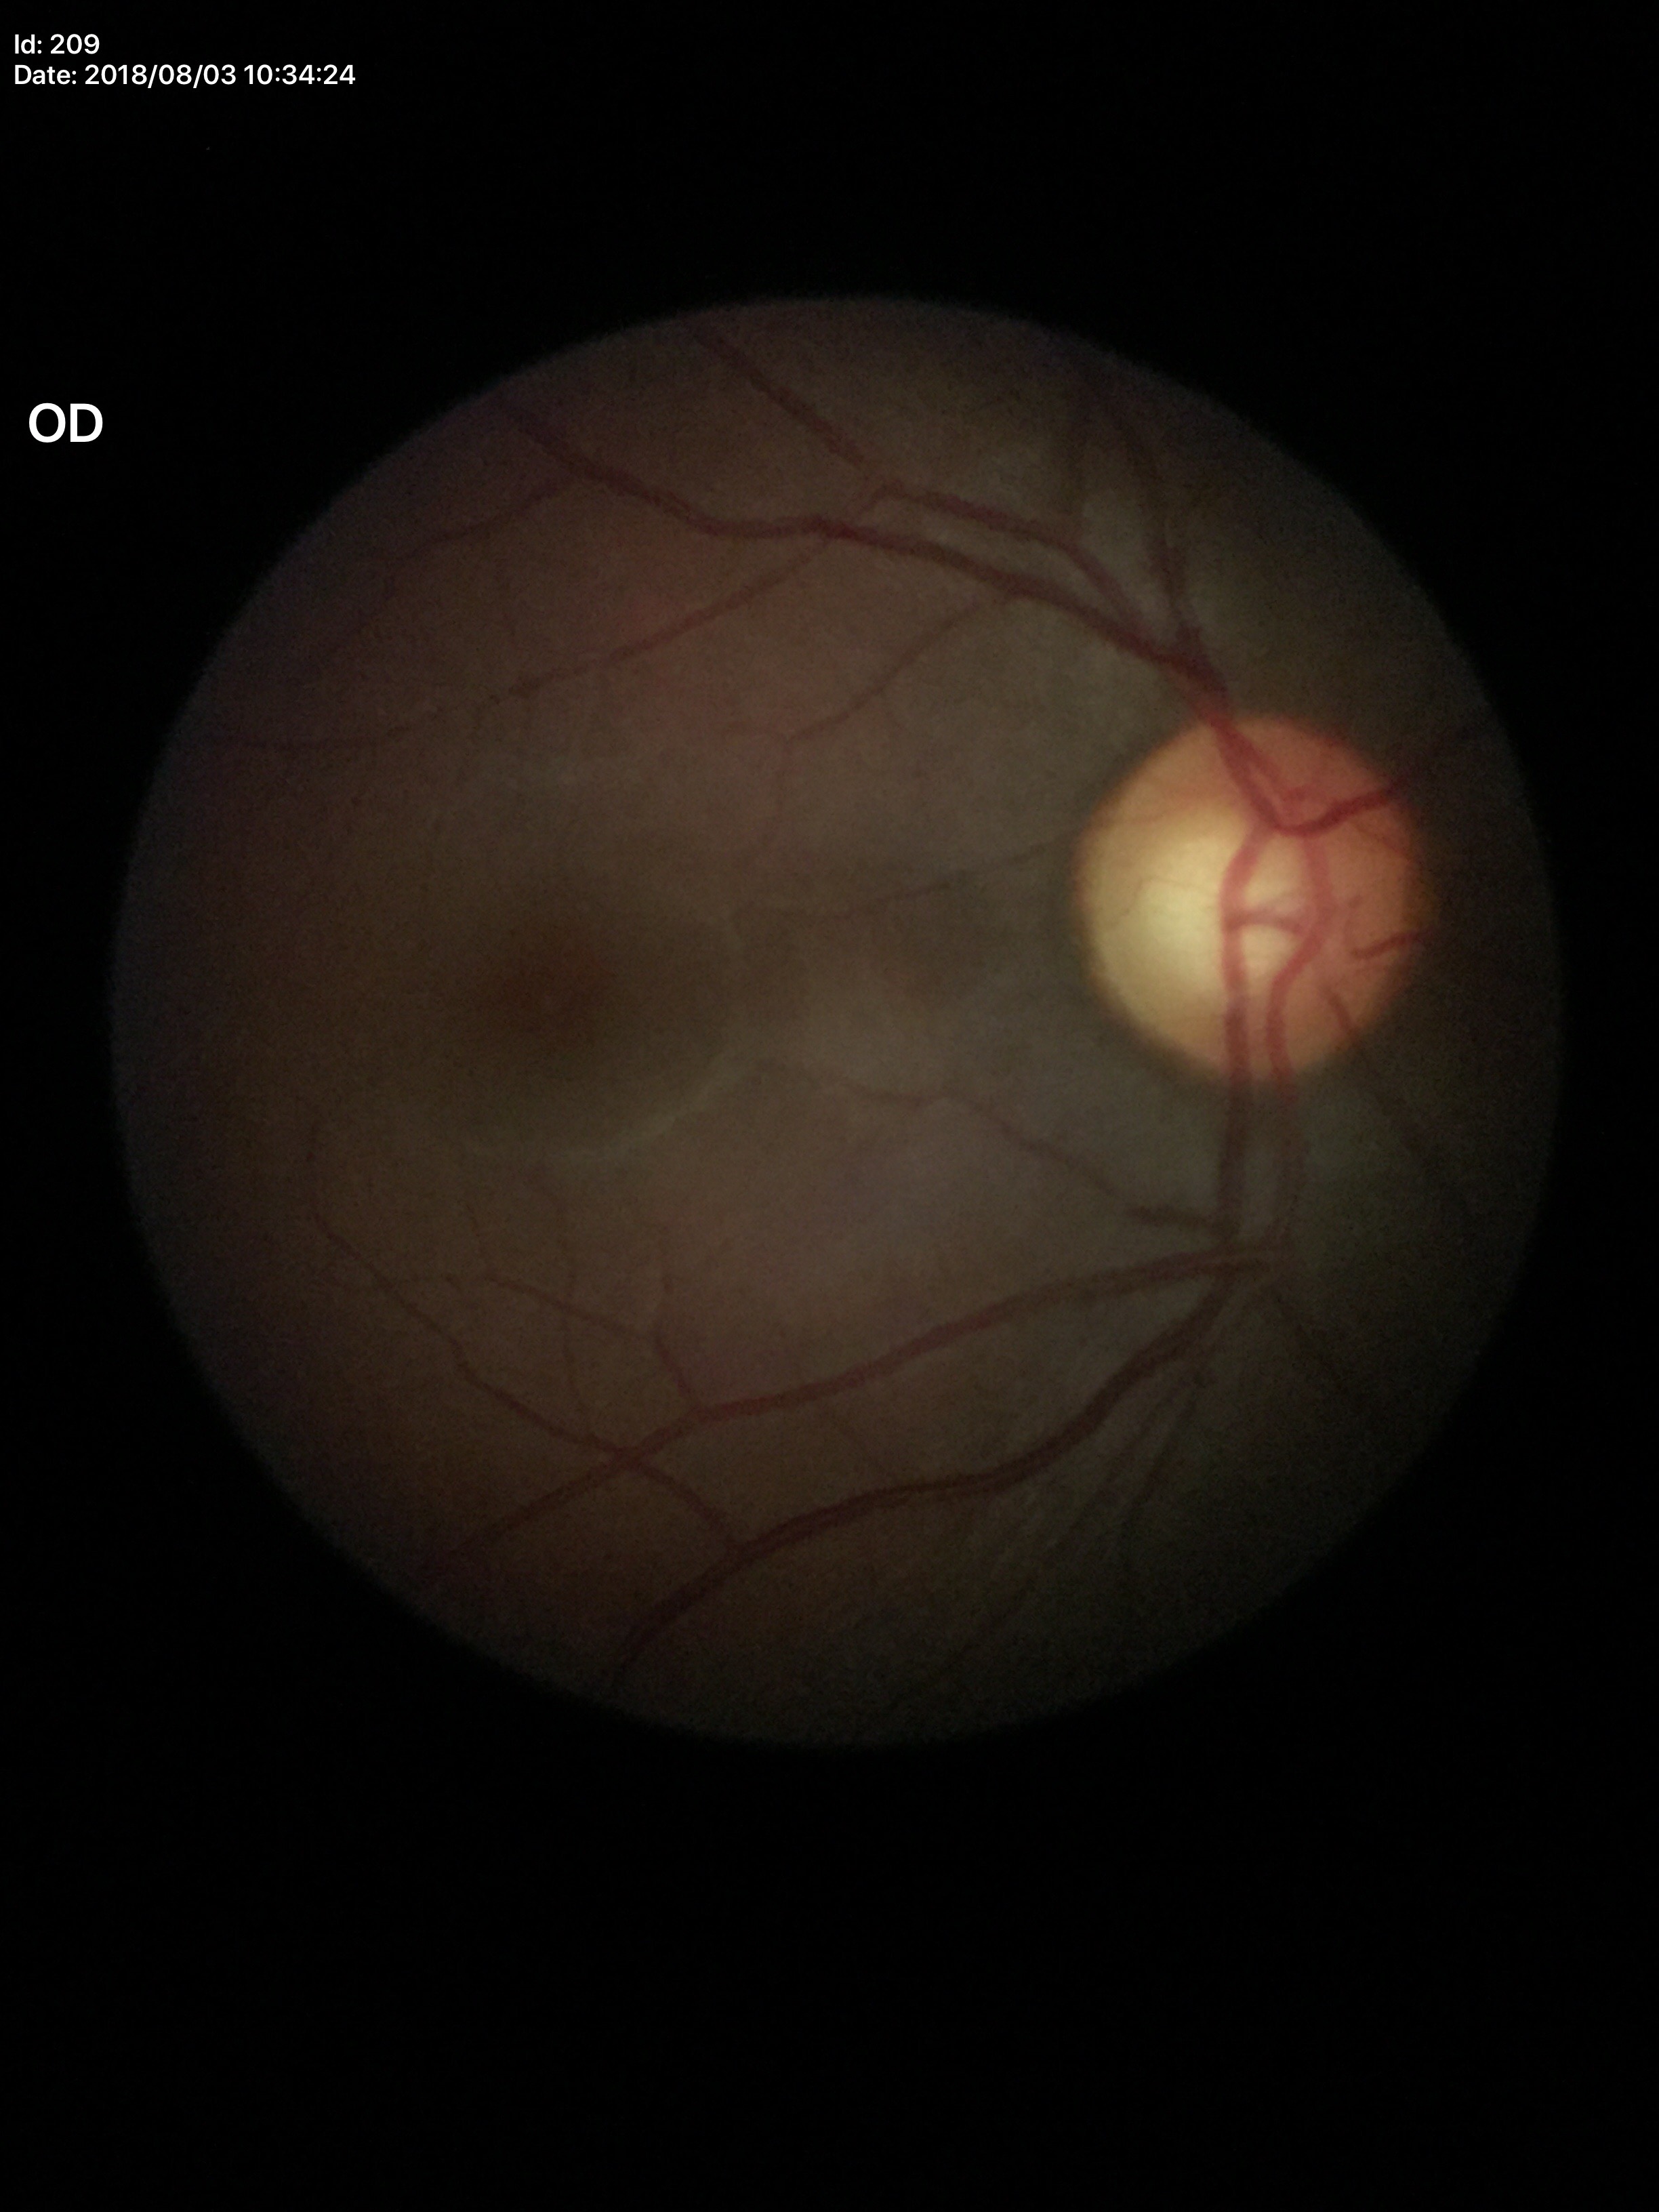

* Glaucoma impression: not suspect
* vertical cup-to-disc ratio (VCDR): 0.54
* horizontal C/D ratio (HCDR): 0.57